Image size 848x848; camera: NIDEK AFC-230: 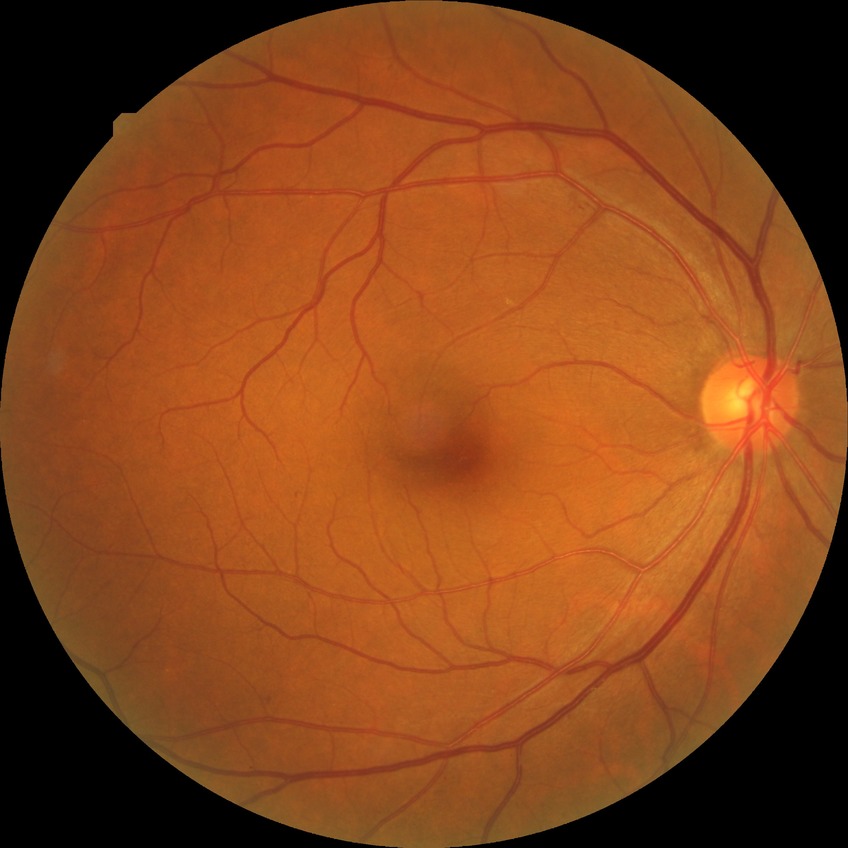   proliferative_class: non-proliferative diabetic retinopathy
  davis_grade: SDR (simple diabetic retinopathy)